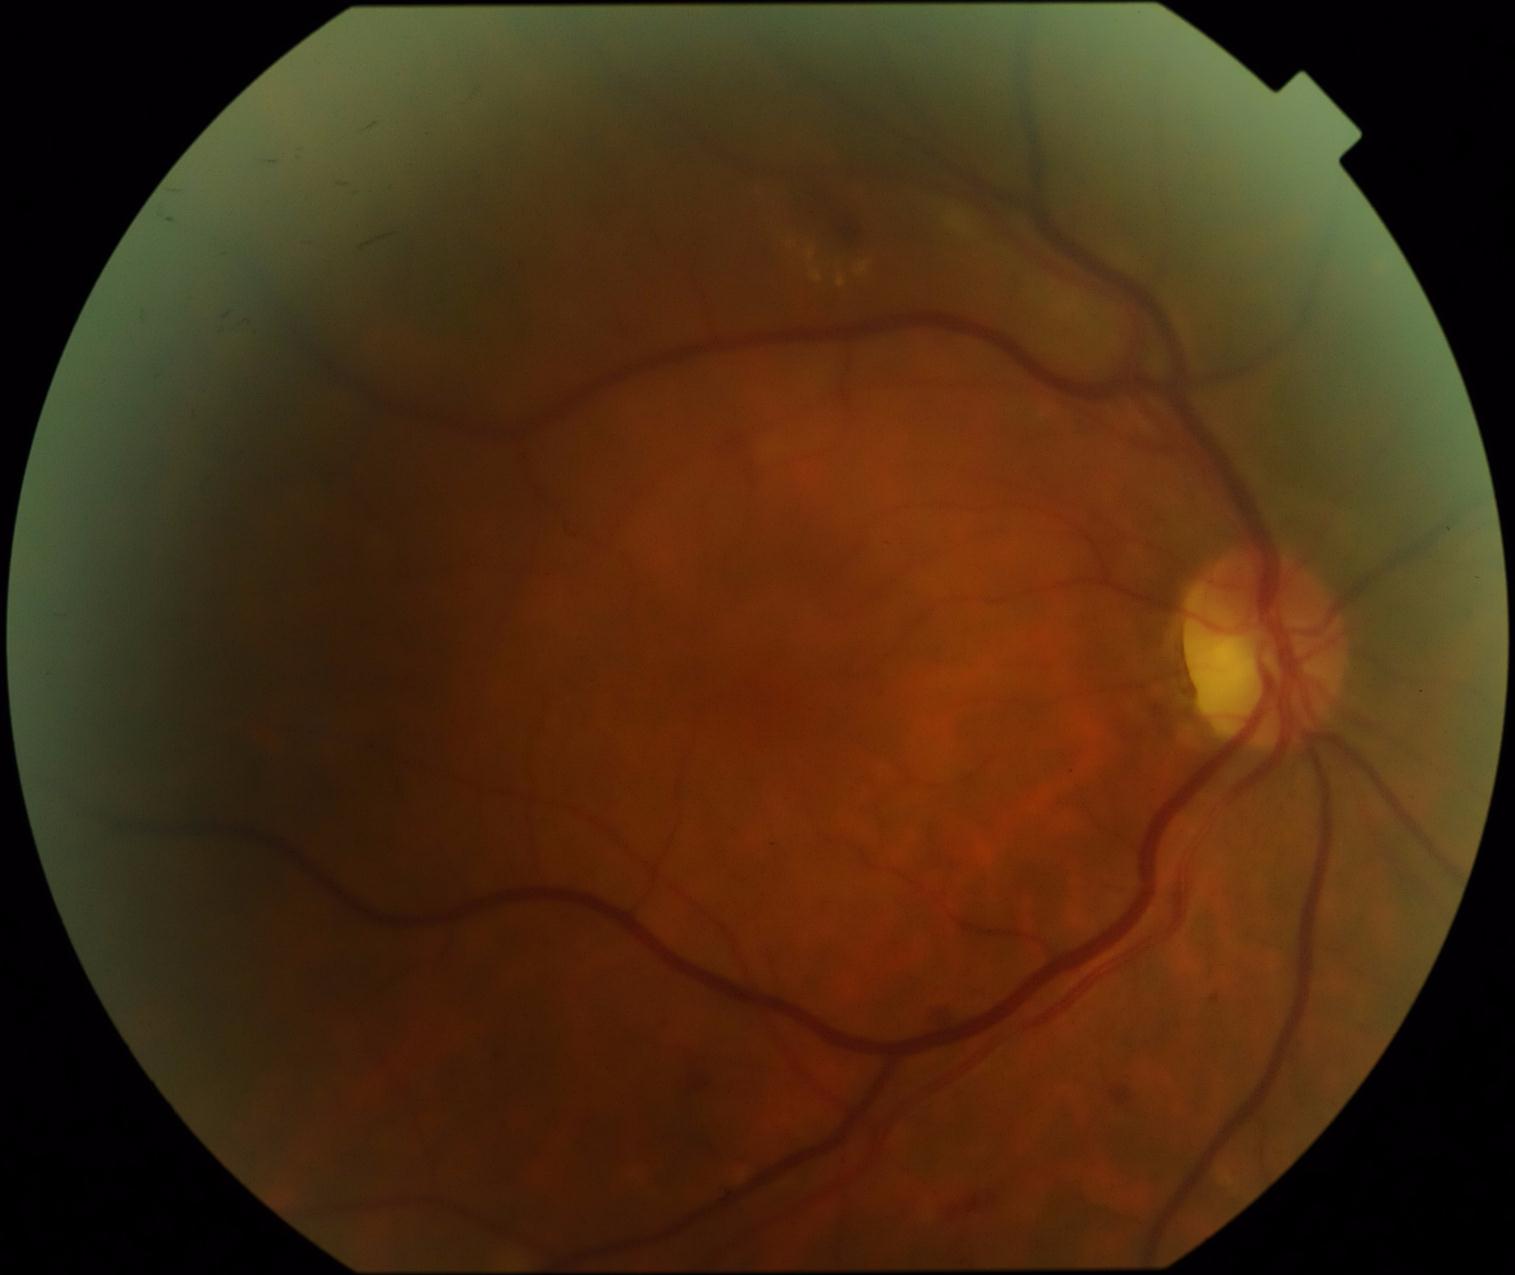
DR grade: moderate non-proliferative diabetic retinopathy (2) — more than just microaneurysms but less than severe NPDR.